45-degree field of view, image size 2352x1568, color fundus image.
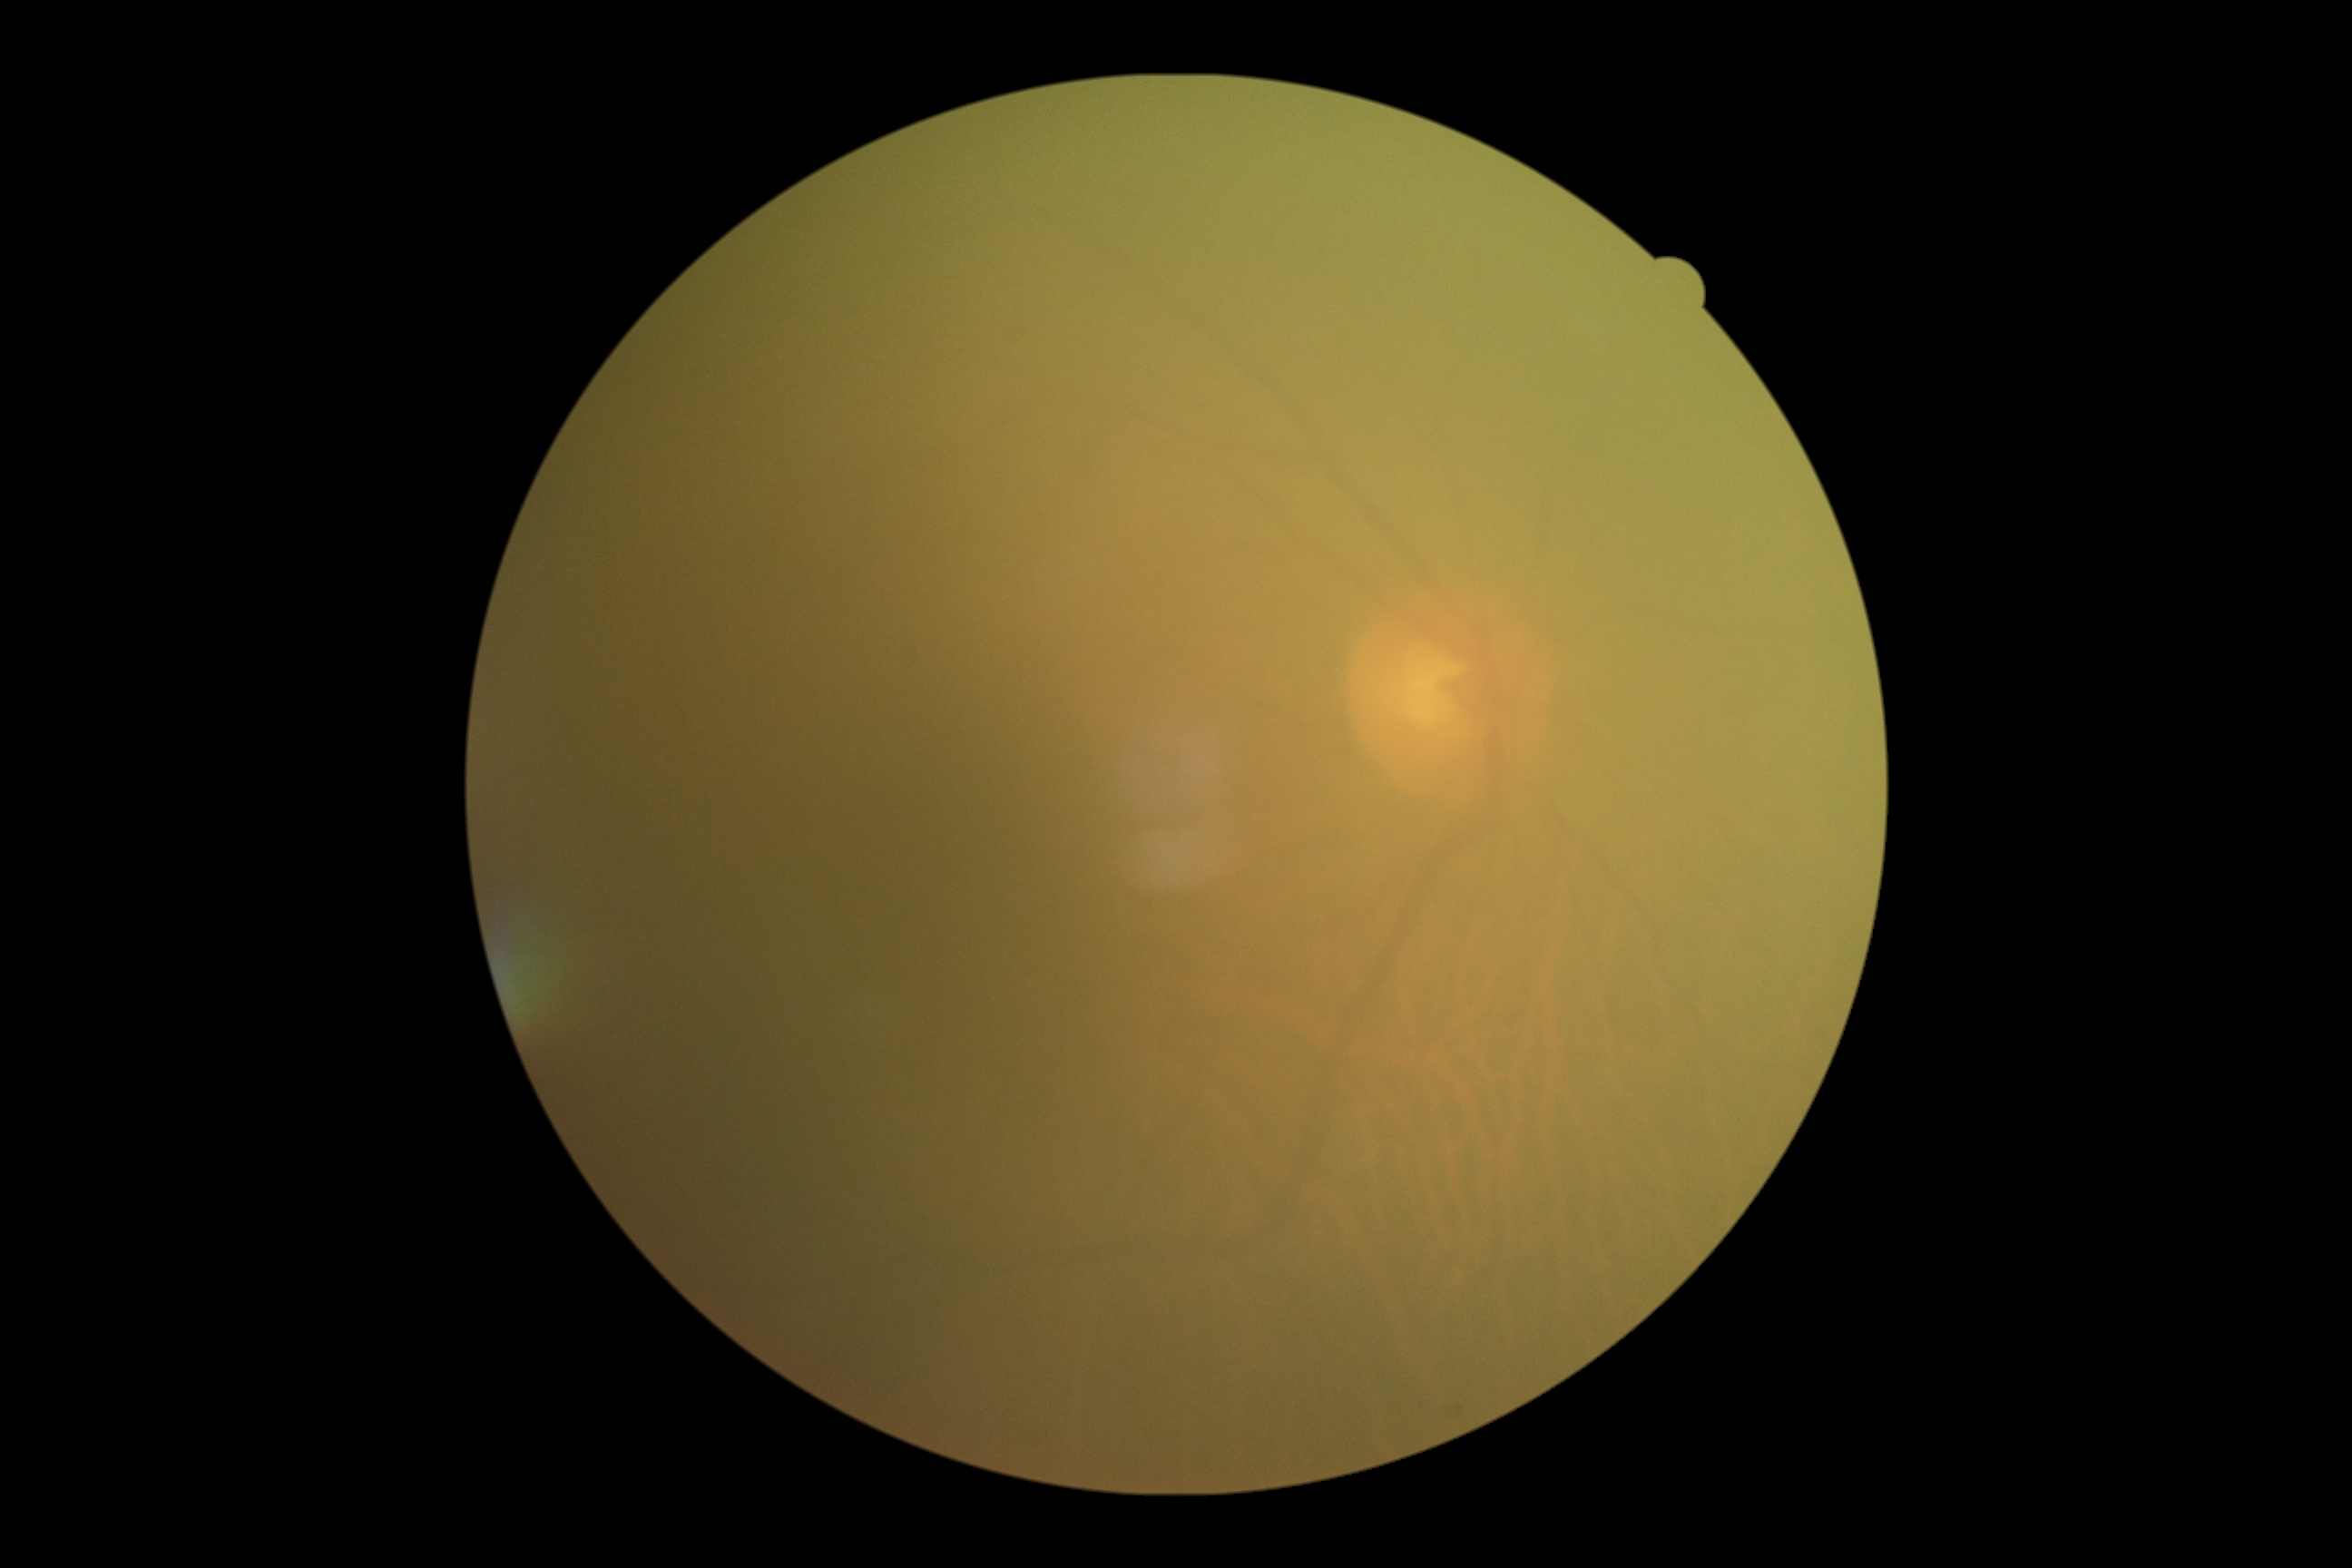 {
  "dr_grade": "ungradable due to poor image quality"
}